Image size 1240x1240. Infant wide-field retinal image. Camera: Phoenix ICON (100° FOV):
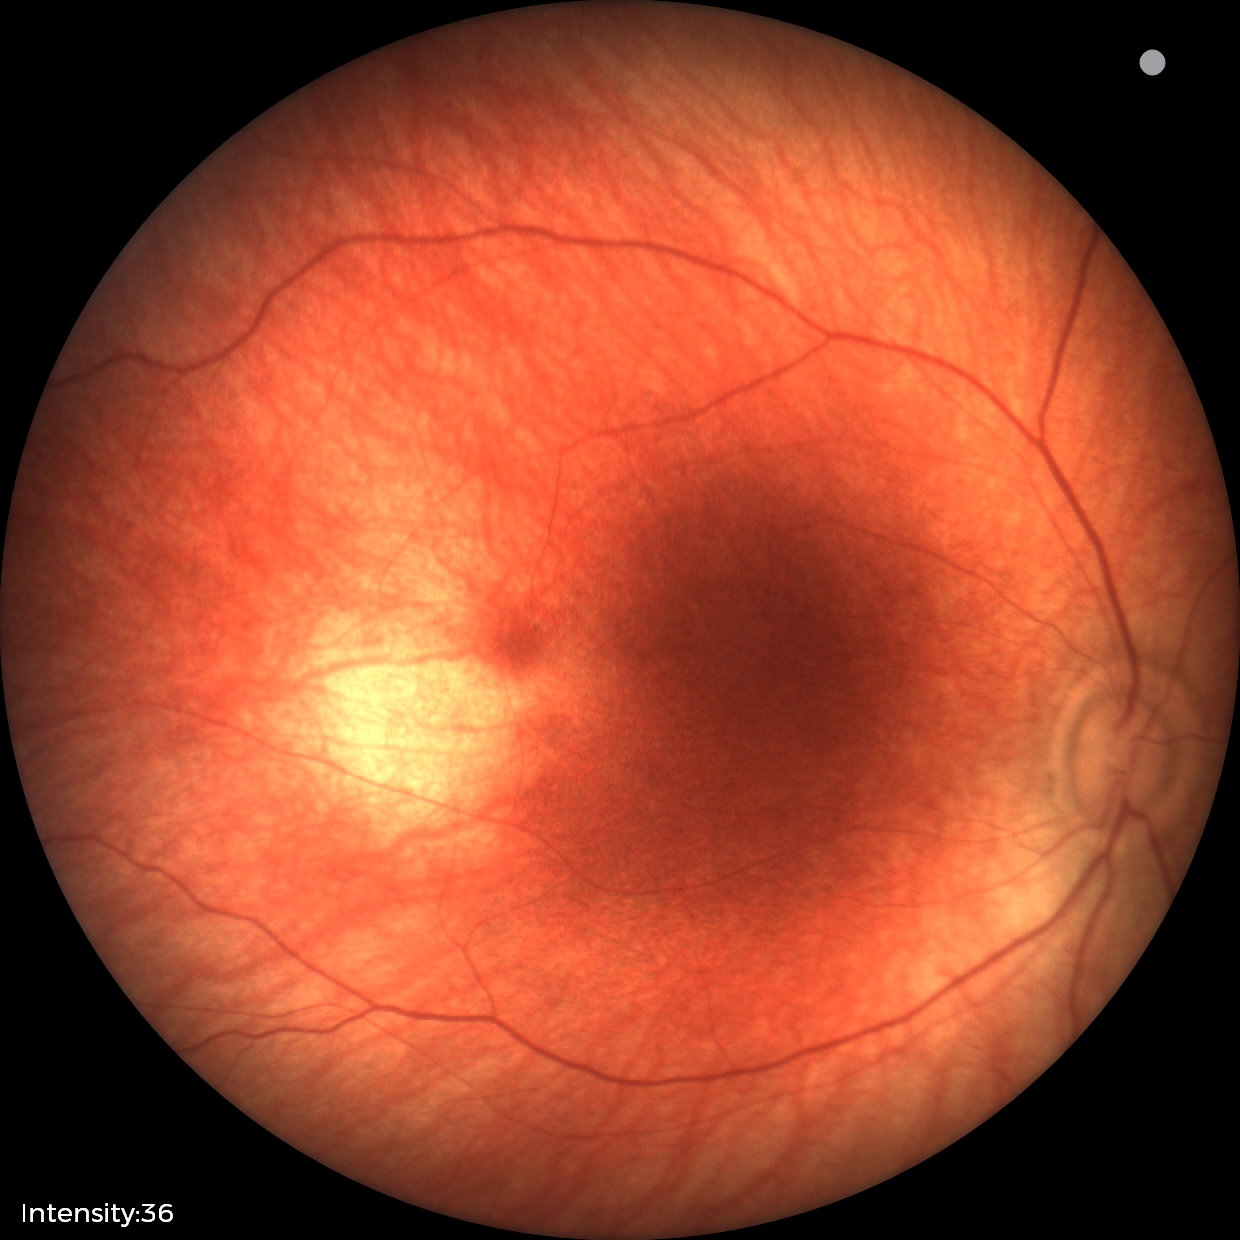

Q: What was the screening finding?
A: normal retinal appearance